2212 by 1659 pixels, color fundus photograph, 45° field of view:
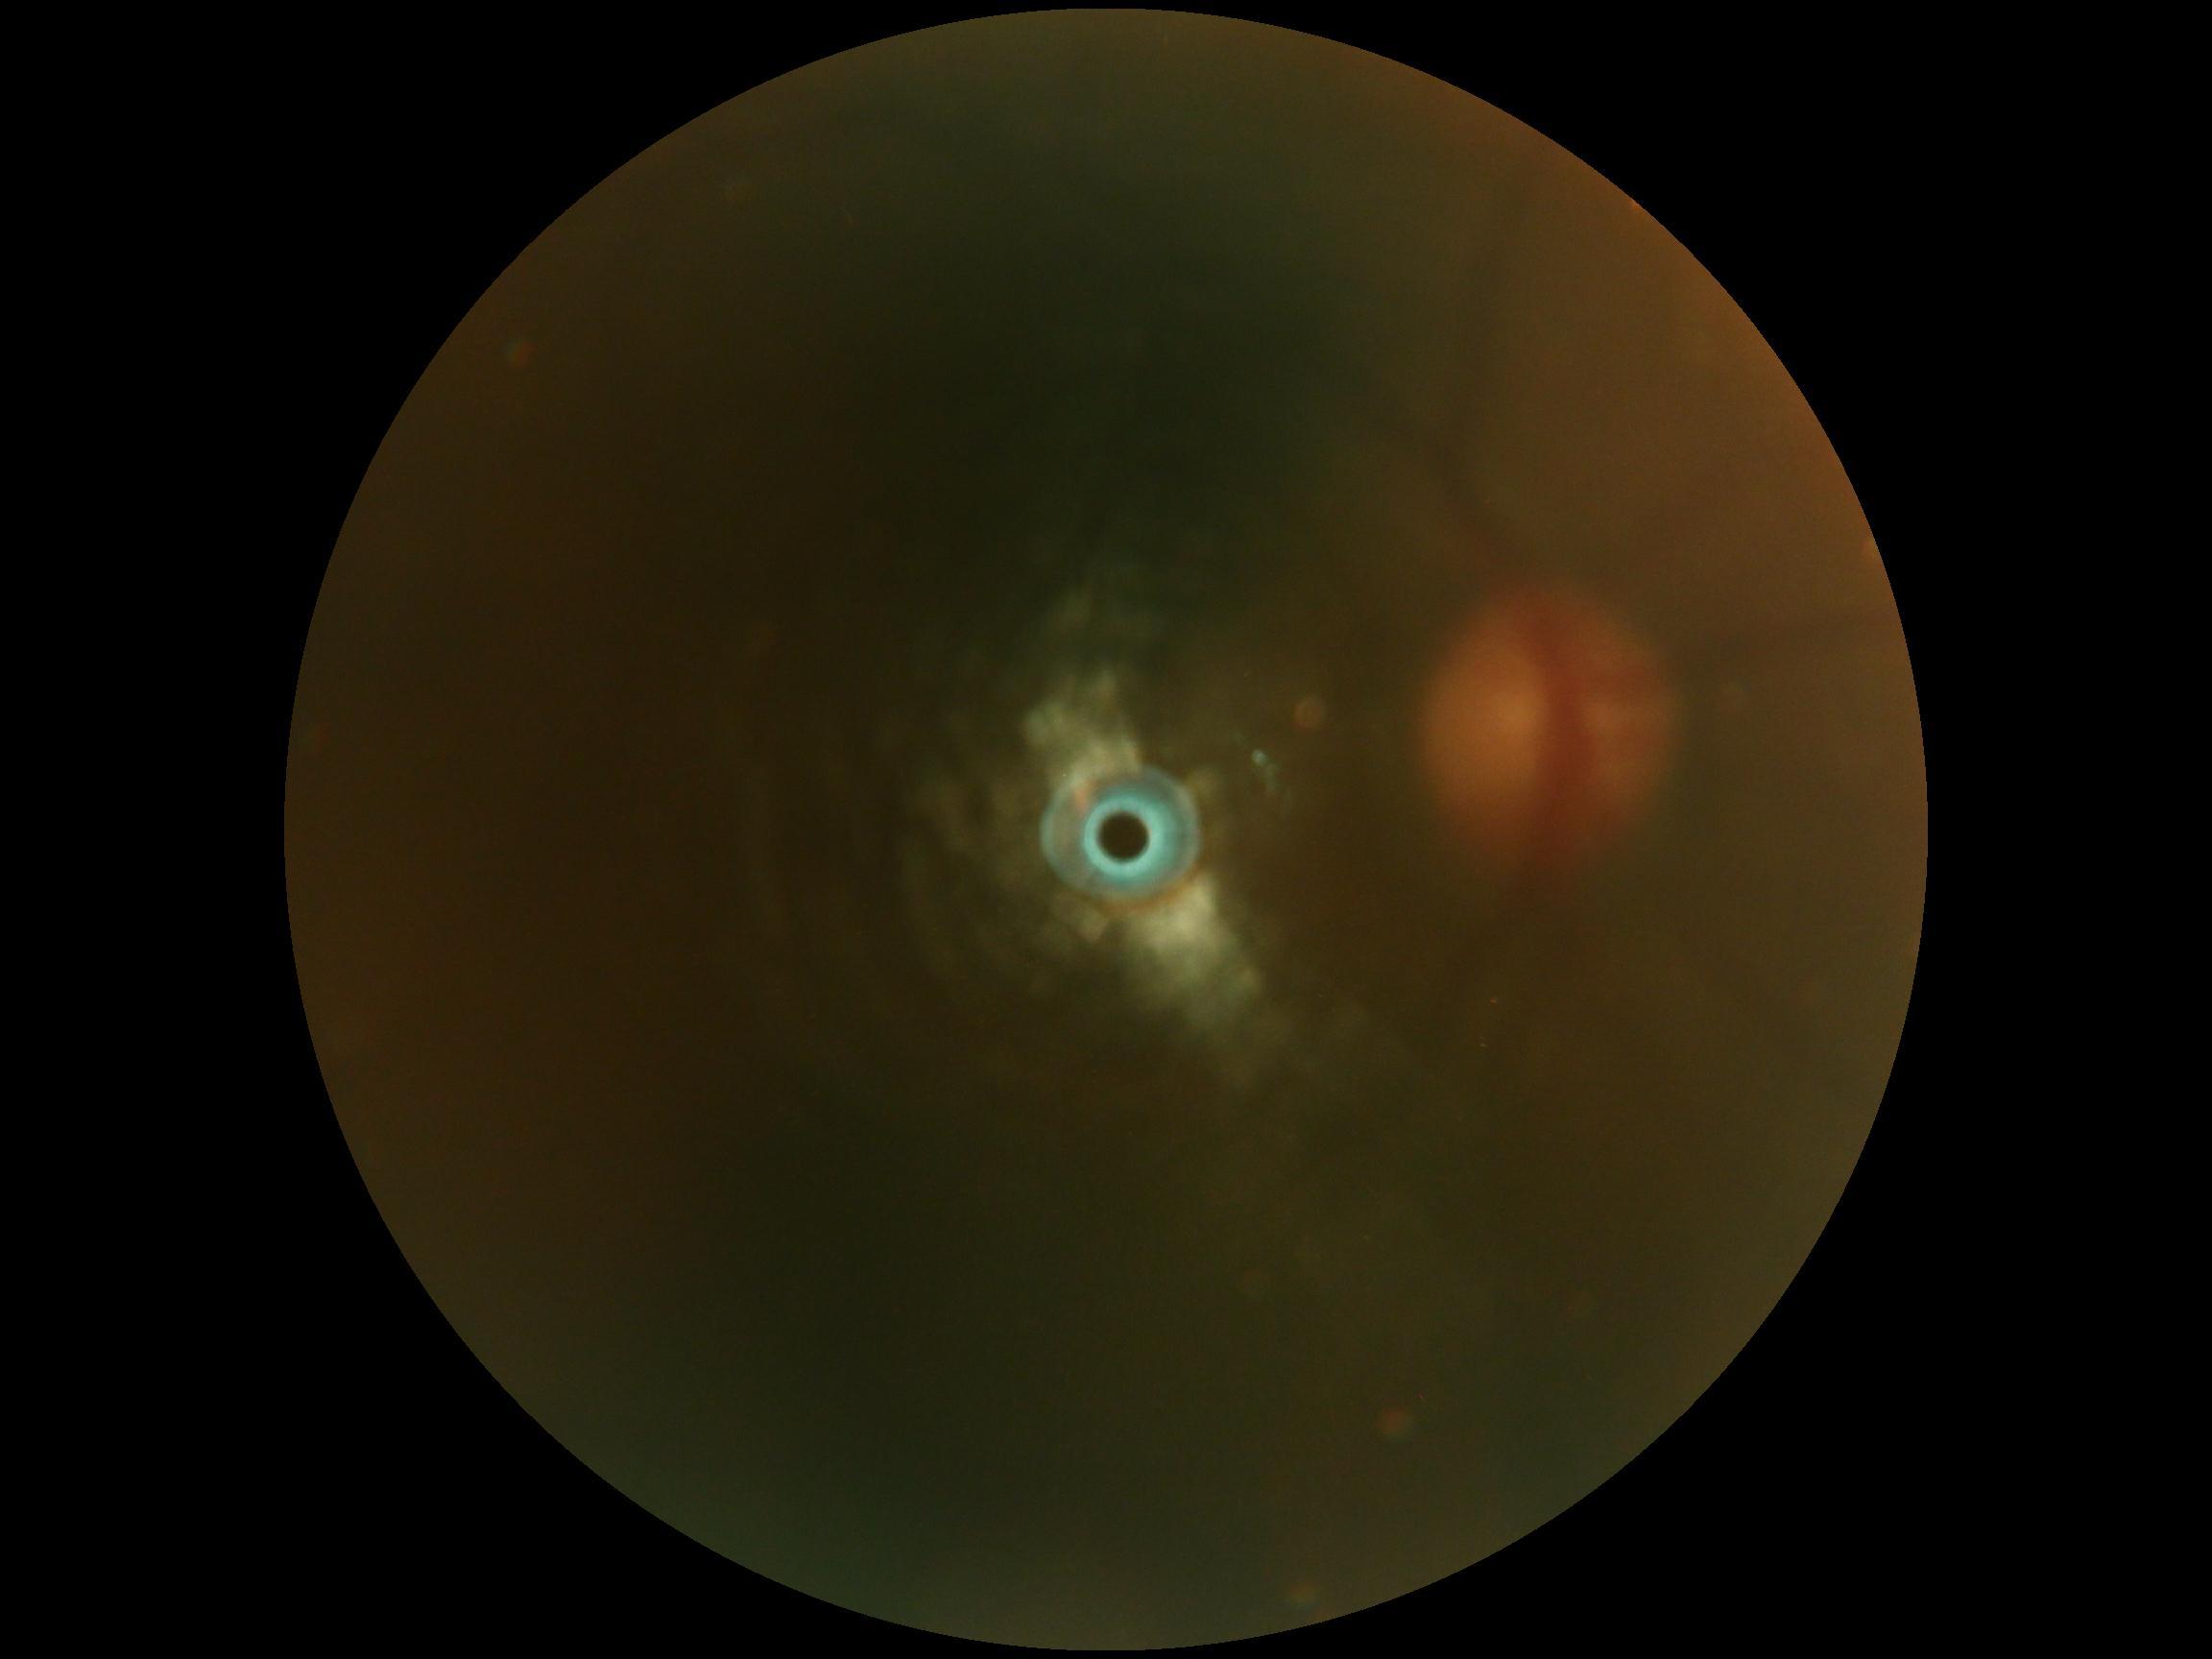

DR: ungradable. The image cannot be graded for diabetic retinopathy.